Modified Davis grading
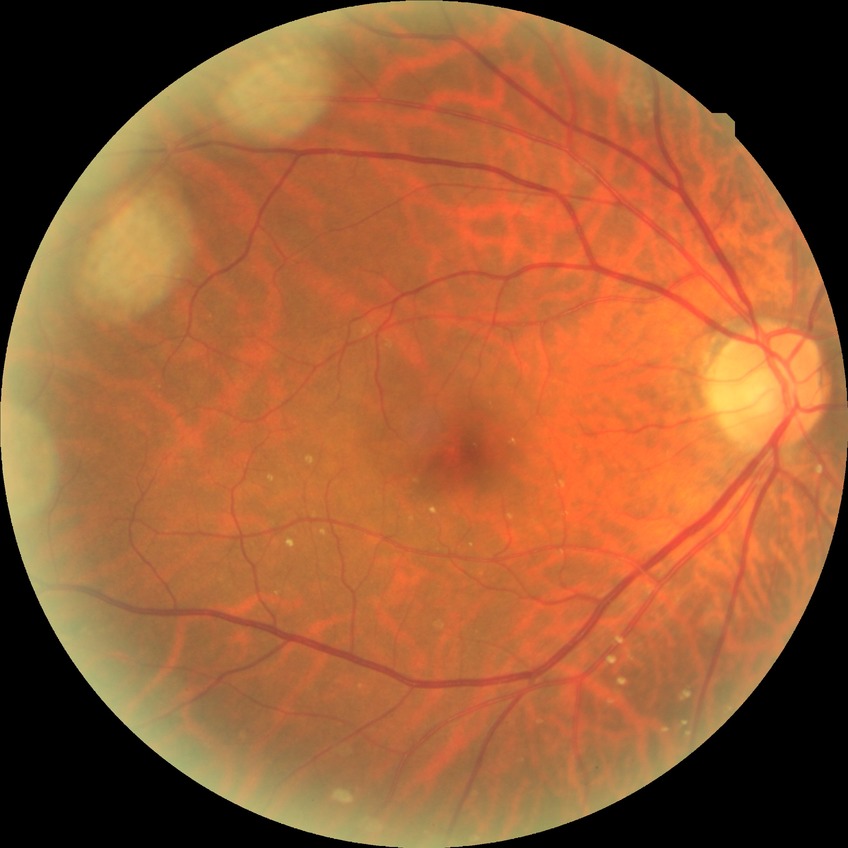 diabetic retinopathy (DR)@no diabetic retinopathy (NDR).